Acquired with a Kowa VX-10α · pupil-dilated · color fundus photograph · 2361 by 1568 pixels:
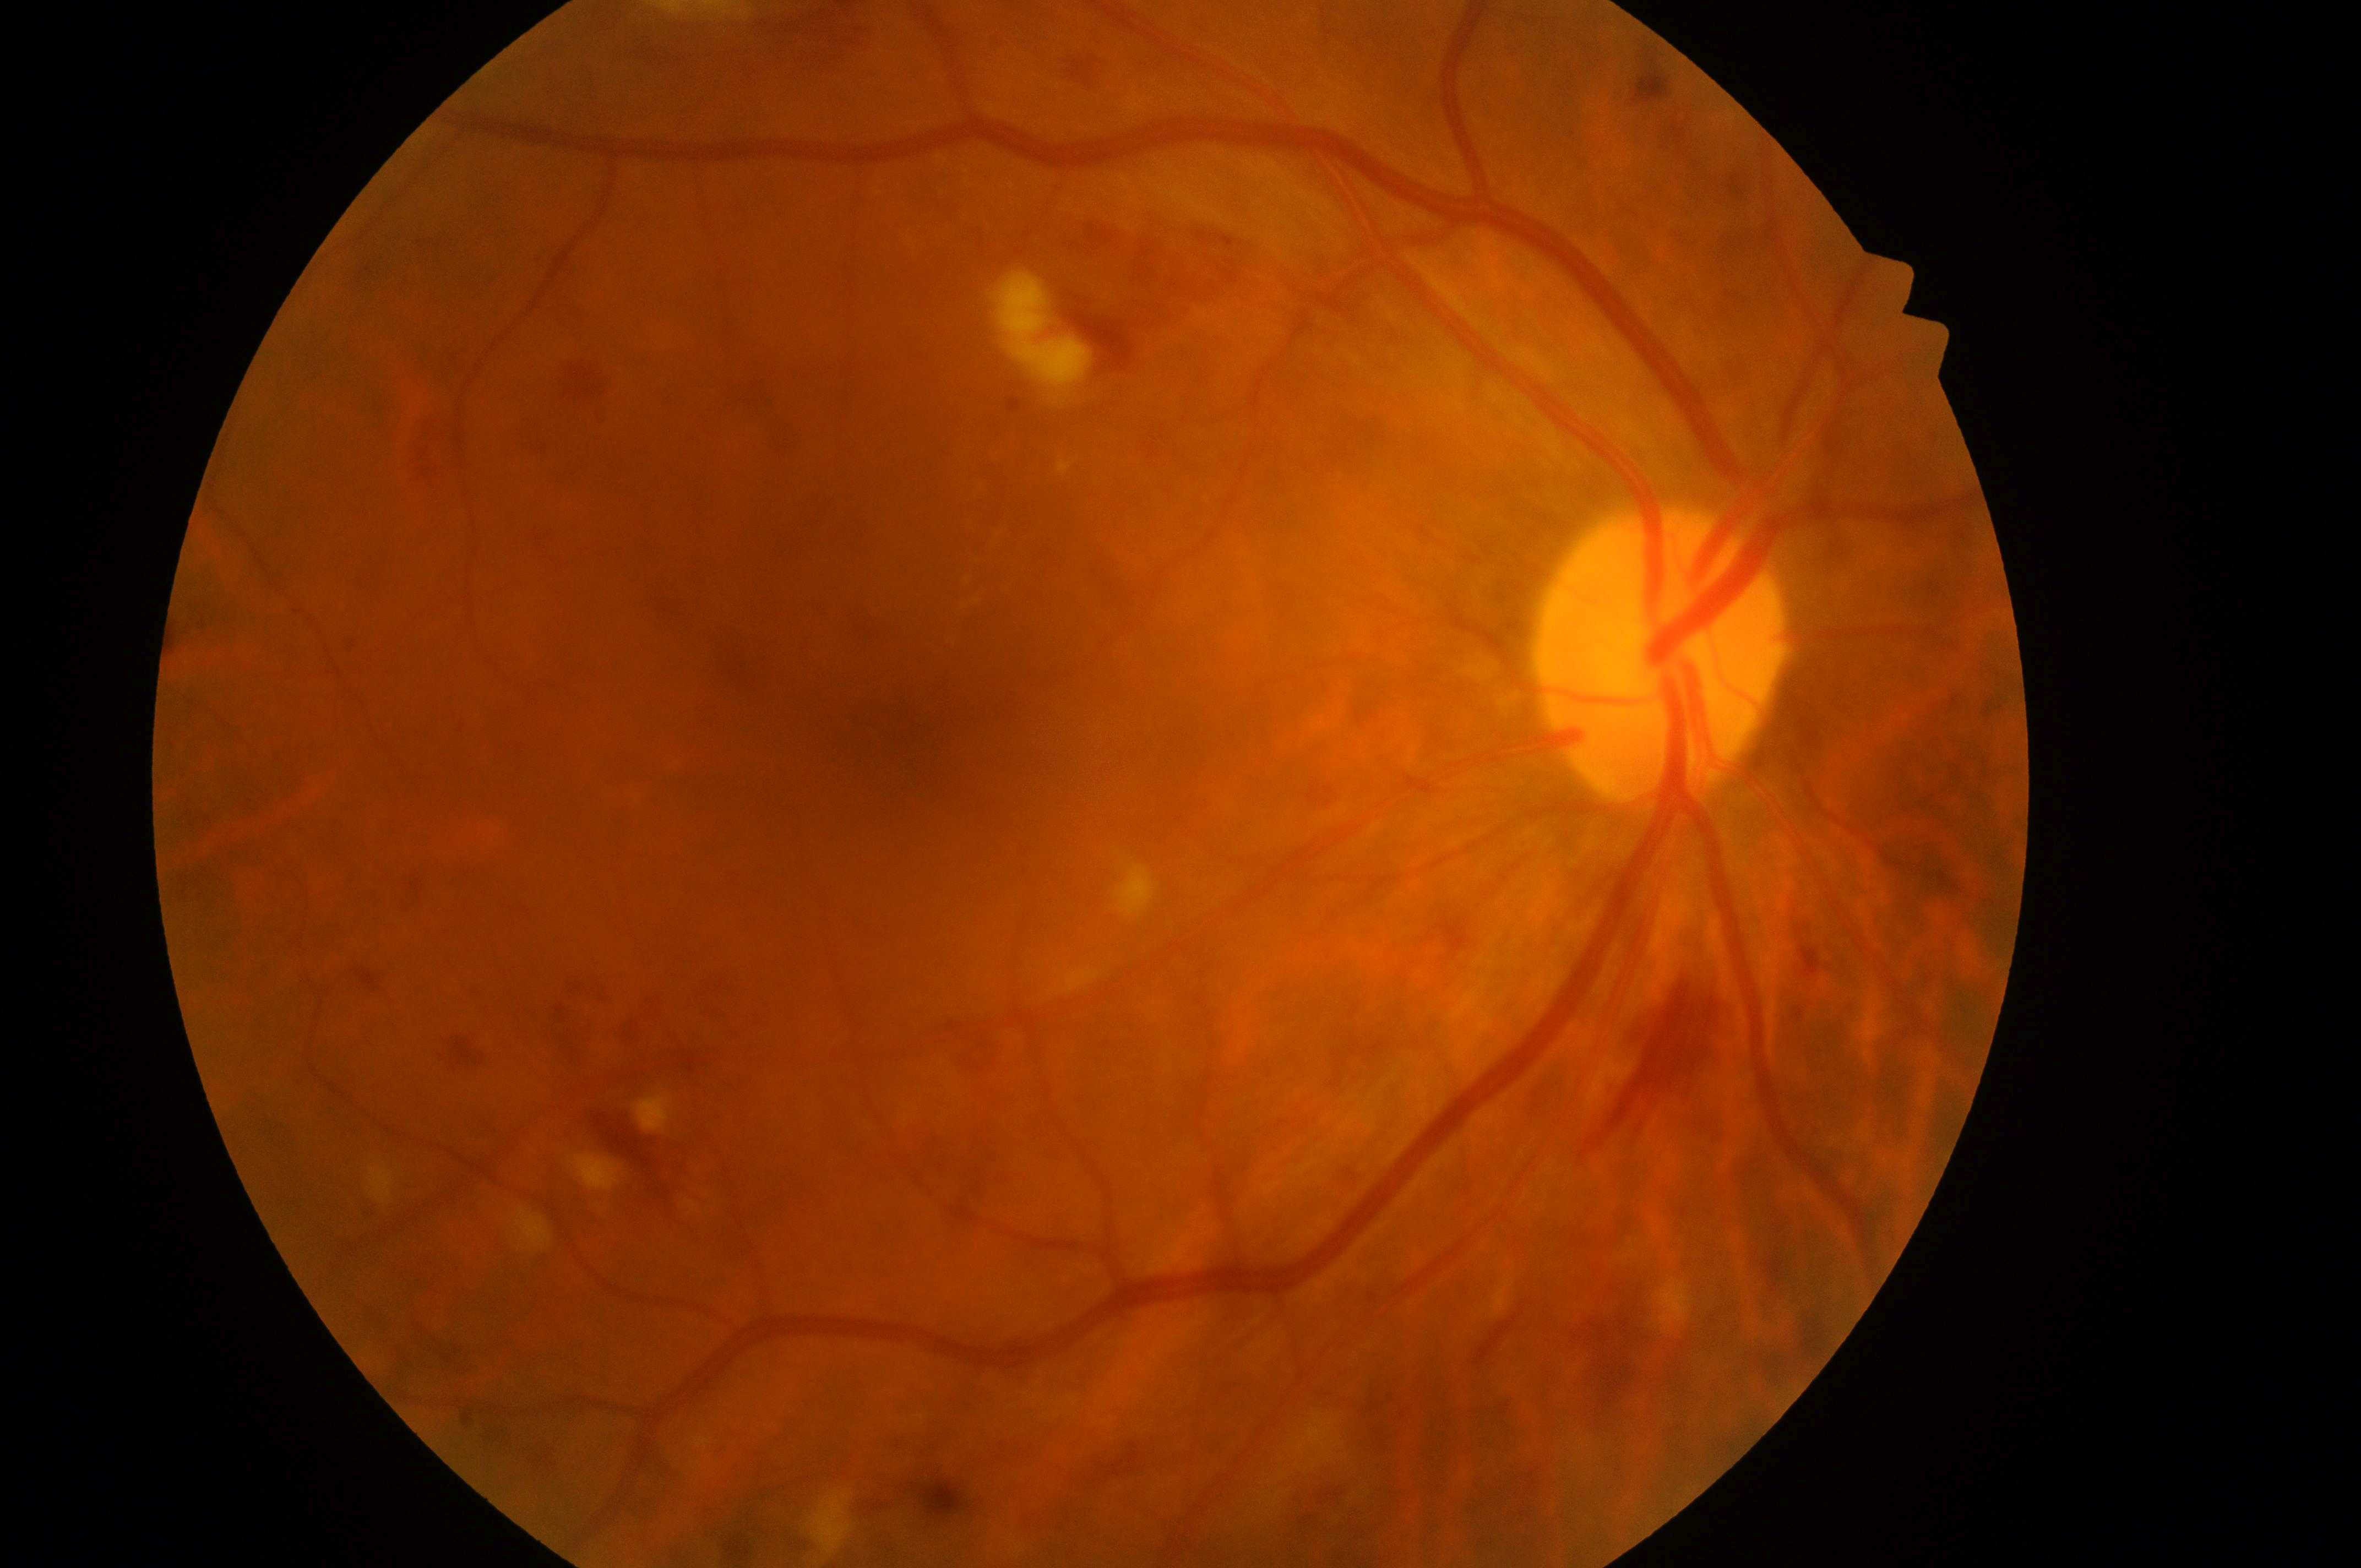
The retinopathy is classified as non-proliferative diabetic retinopathy. The optic disc is at (x: 1650, y: 663). Eye: right. Fovea: (x: 901, y: 744). Macular edema risk is 2. Retinopathy grade is 3.